Posterior pole photograph, nonmydriatic, 45° FOV, 848x848px: 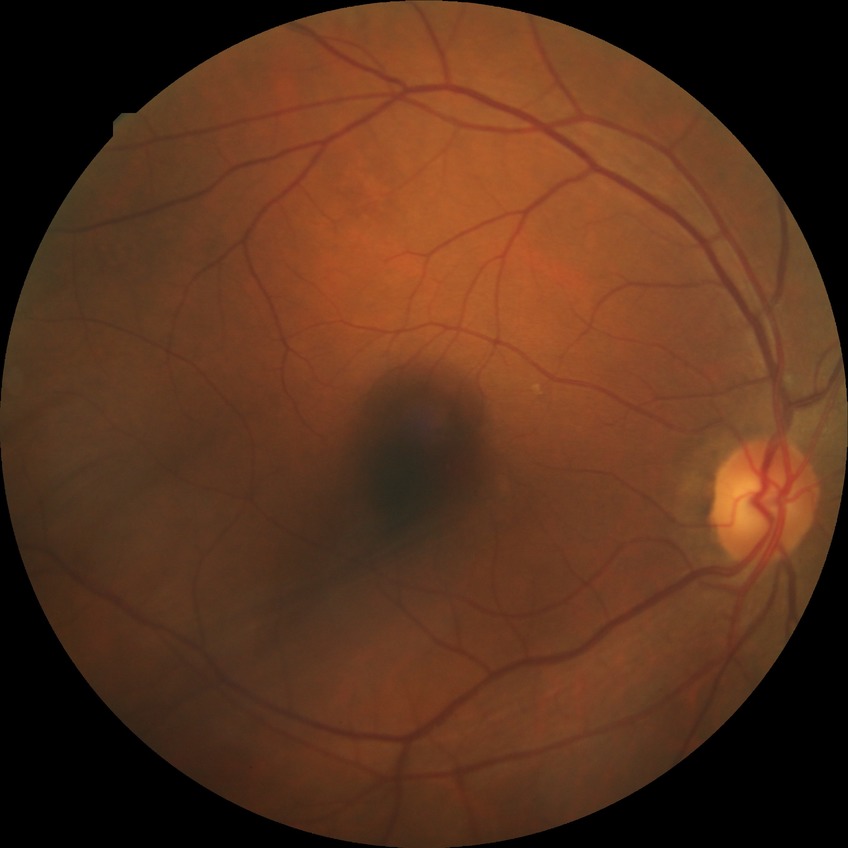

Davis grading: no diabetic retinopathy.